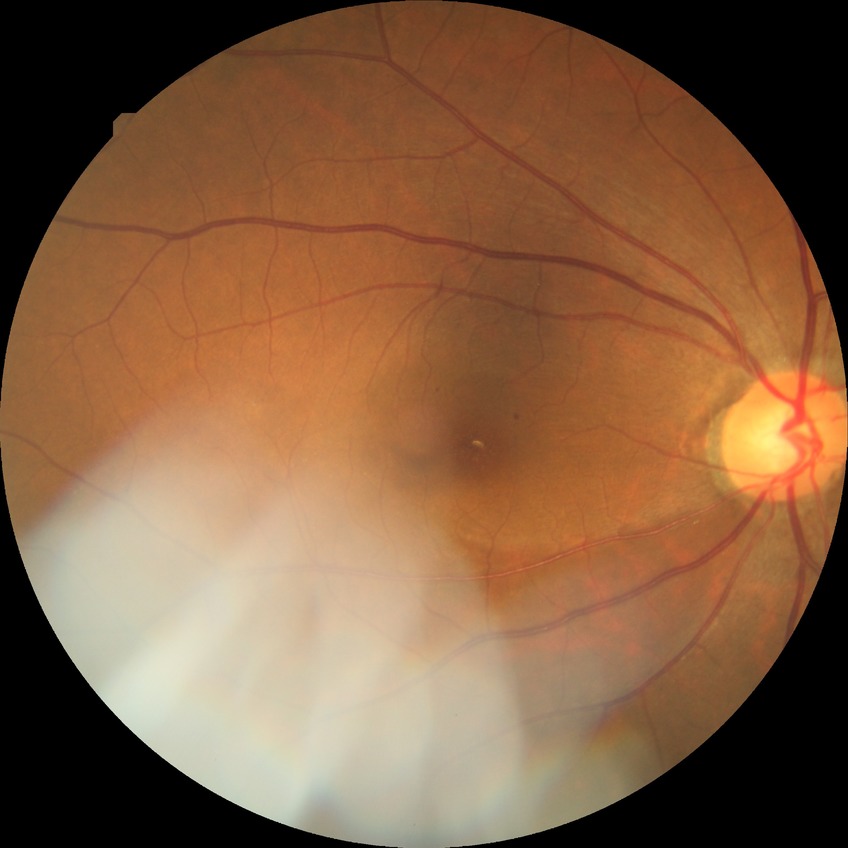

DR@SDR.